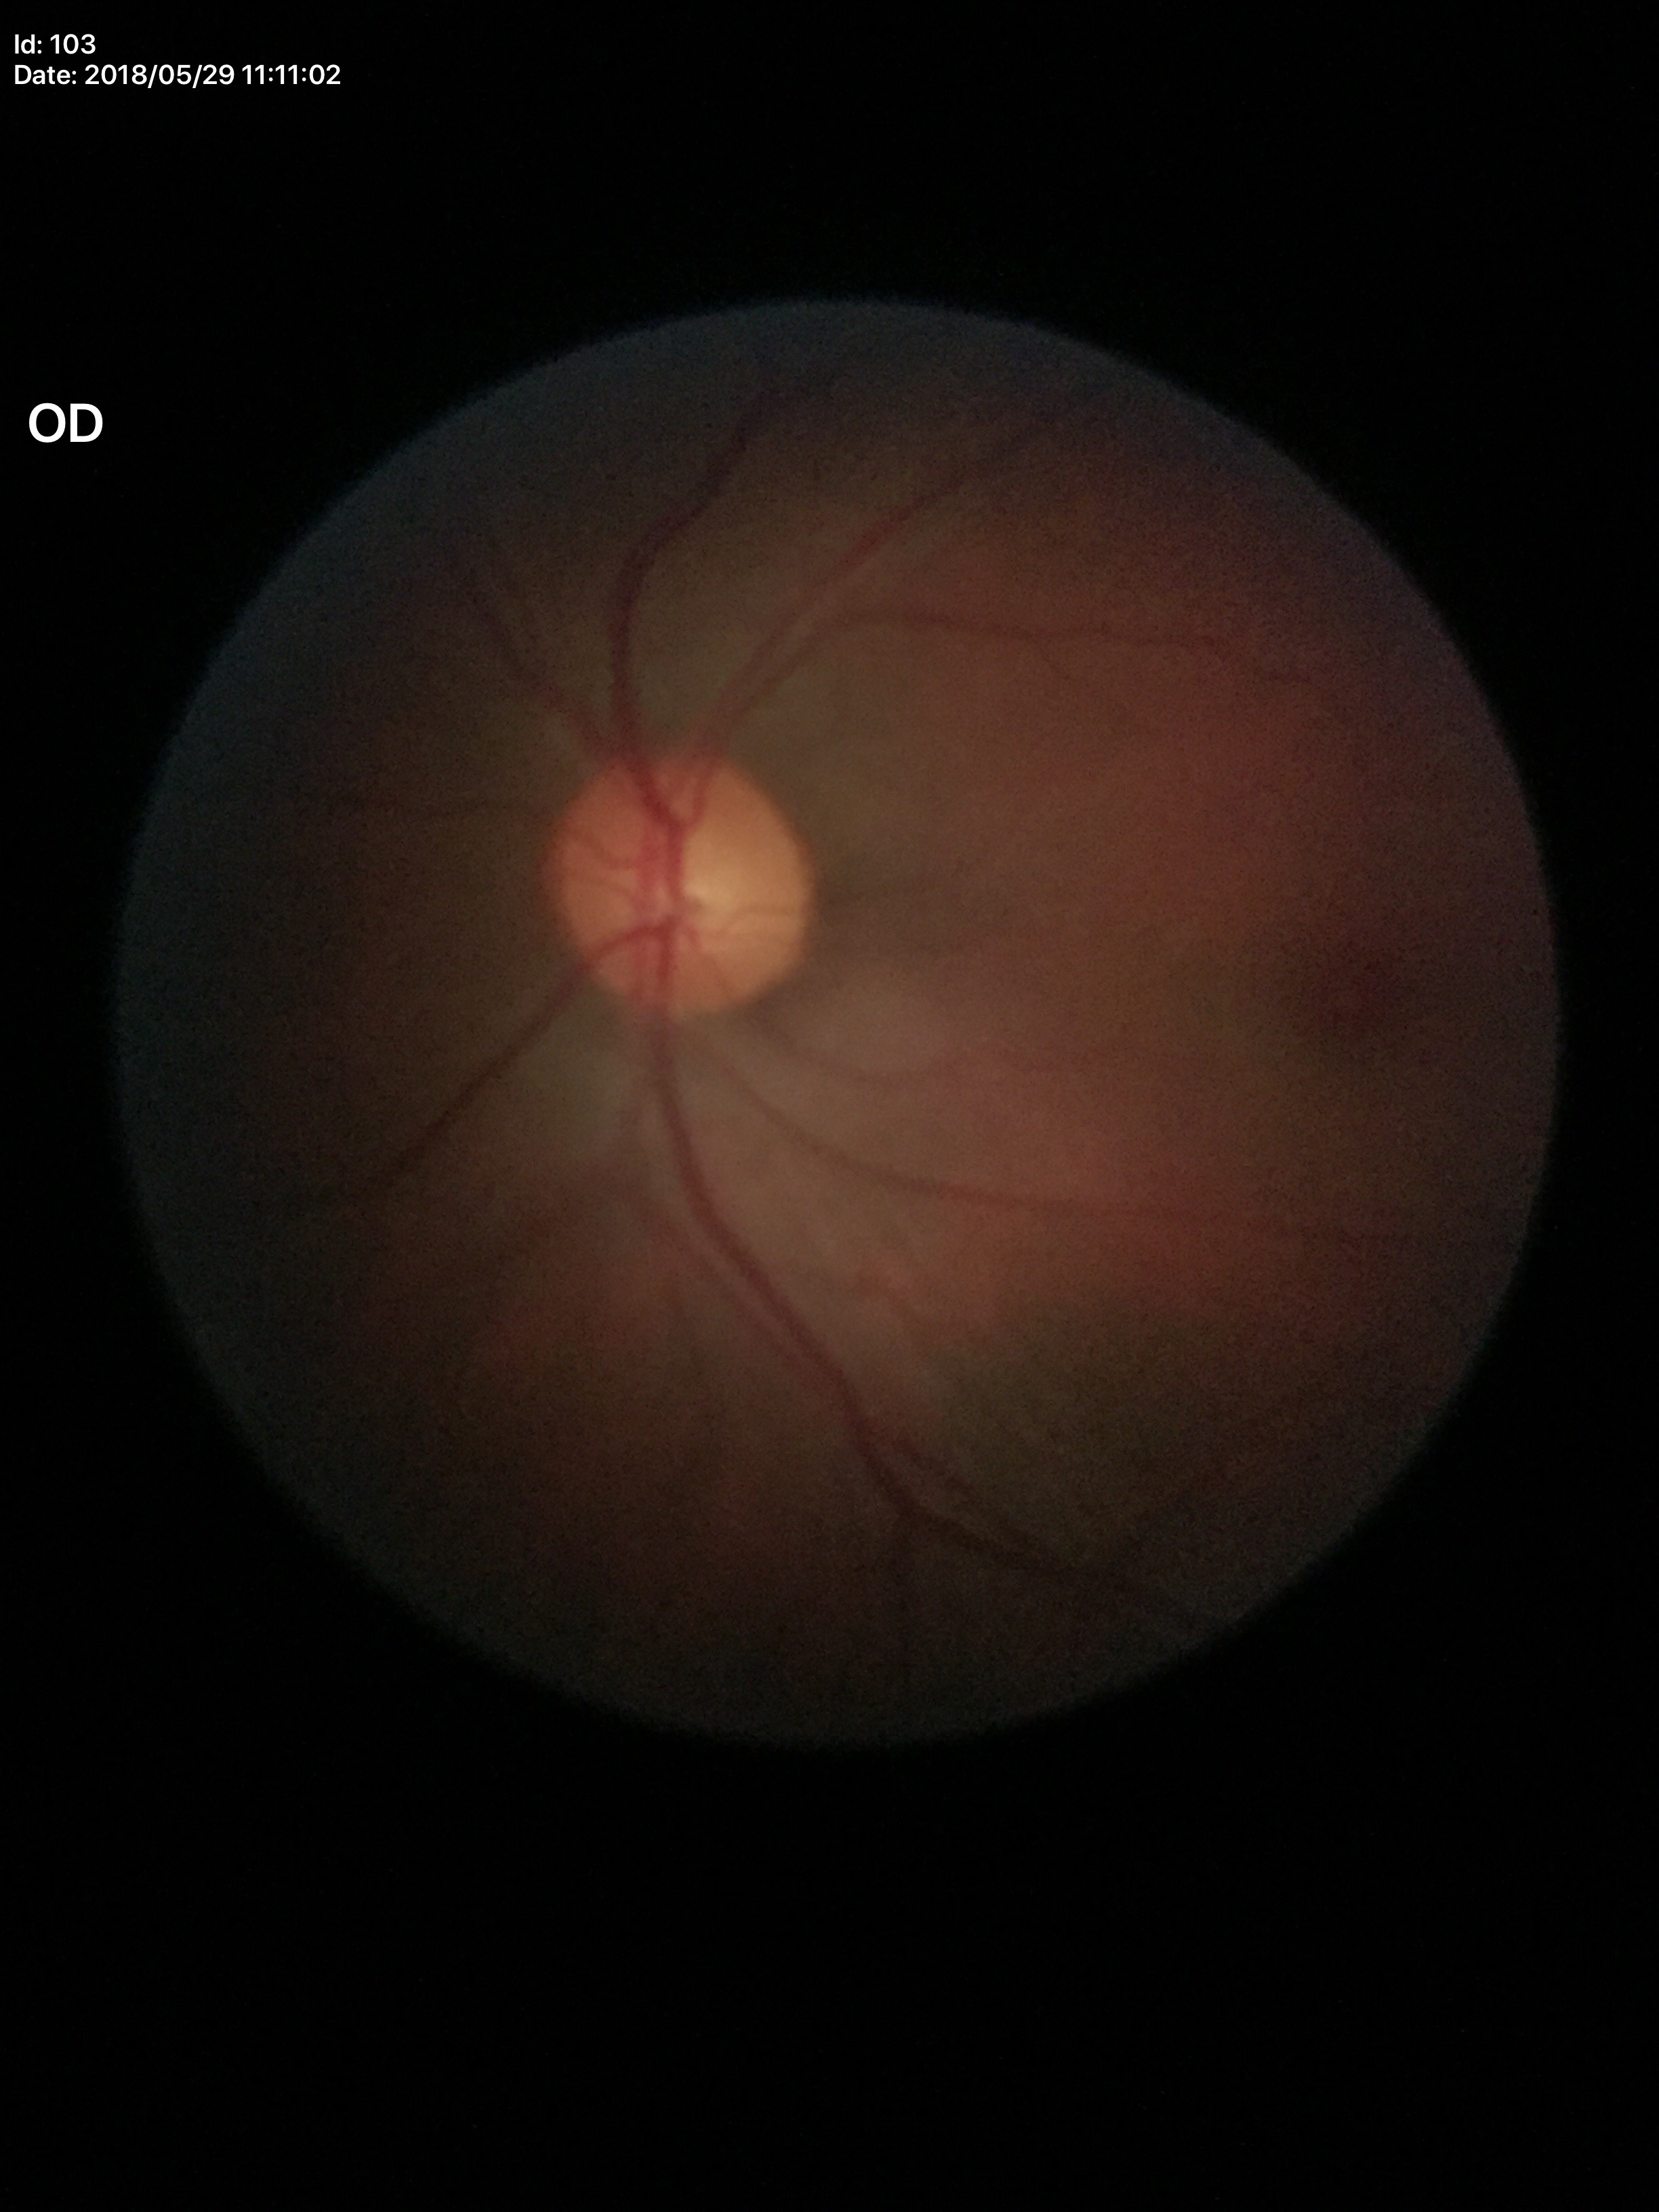 Optic disc analysis:
• Glaucoma assessment: negative
• vertical C/D ratio: 0.49